Captured with the Clarity RetCam 3 (130° field of view). 640 by 480 pixels. Pediatric retinal photograph (wide-field):
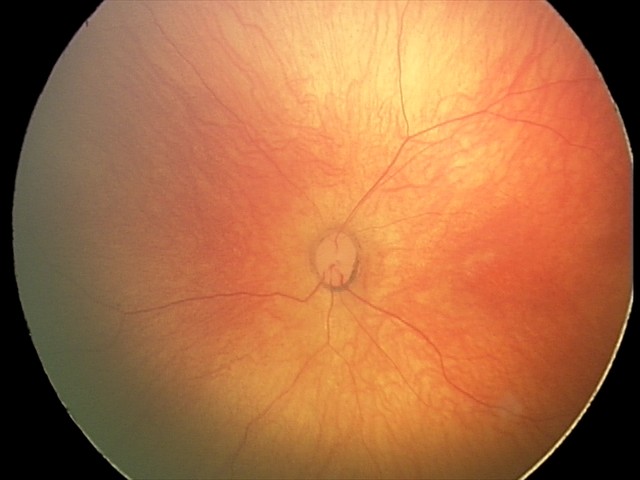
Assessment: physiological finding.